848x848. Nonmydriatic. NIDEK AFC-230. Color fundus photograph: 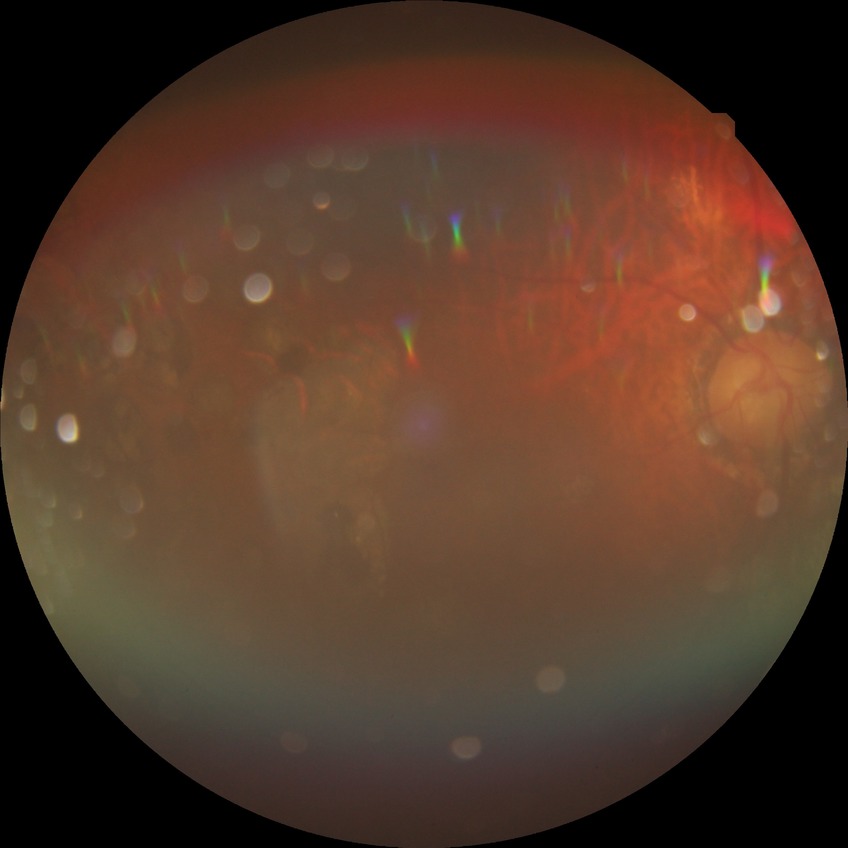 Diabetic retinopathy (DR): proliferative diabetic retinopathy (PDR).